FOV: 45 degrees — 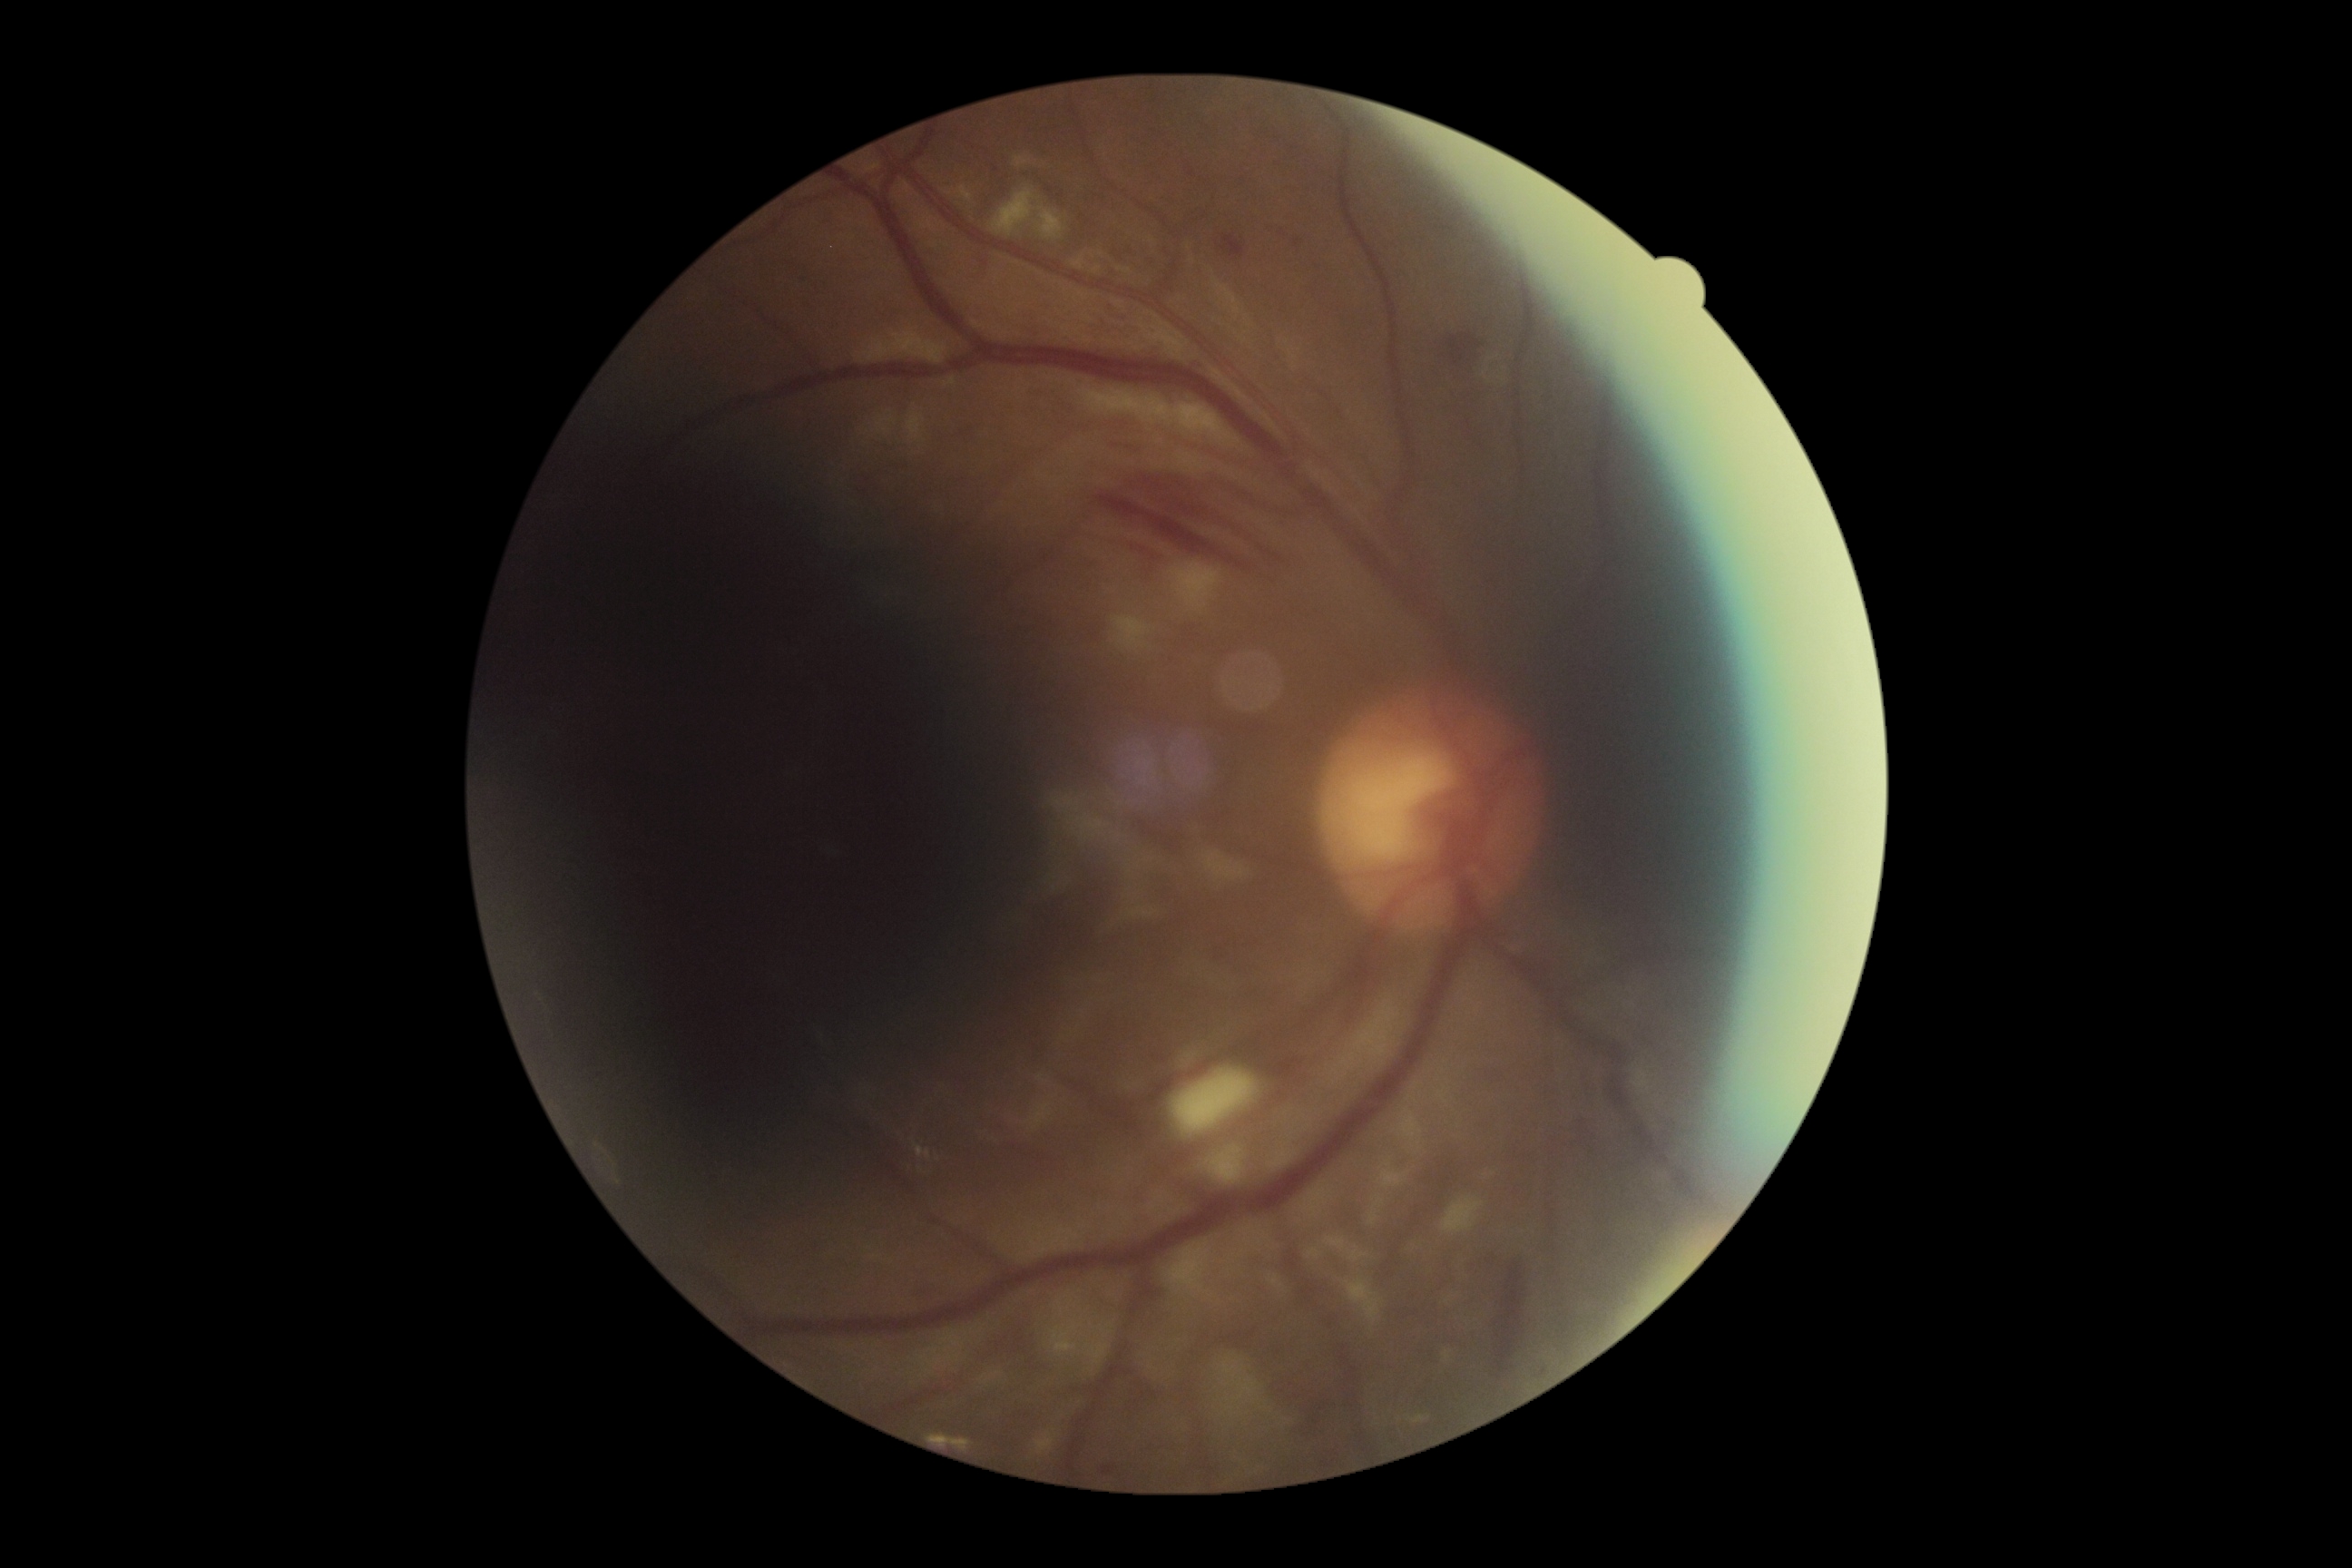

Diabetic retinopathy severity is grade 2.